640x480 · 130° field of view (Clarity RetCam 3) · wide-field fundus photograph from neonatal ROP screening: 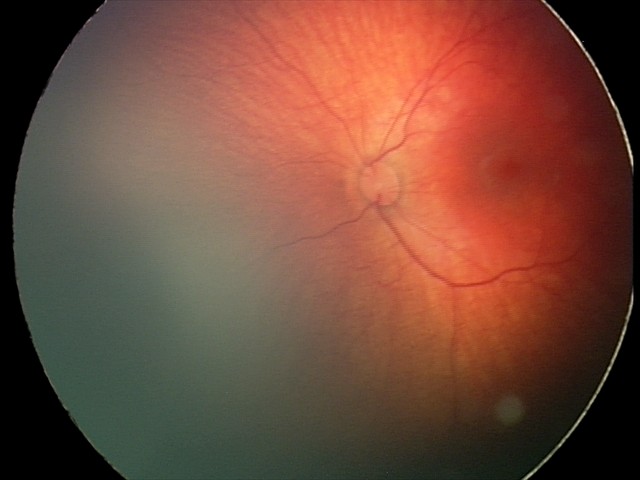

Screening: retinal hemorrhages.